Acquired on the Phoenix ICON. Pediatric wide-field fundus photograph
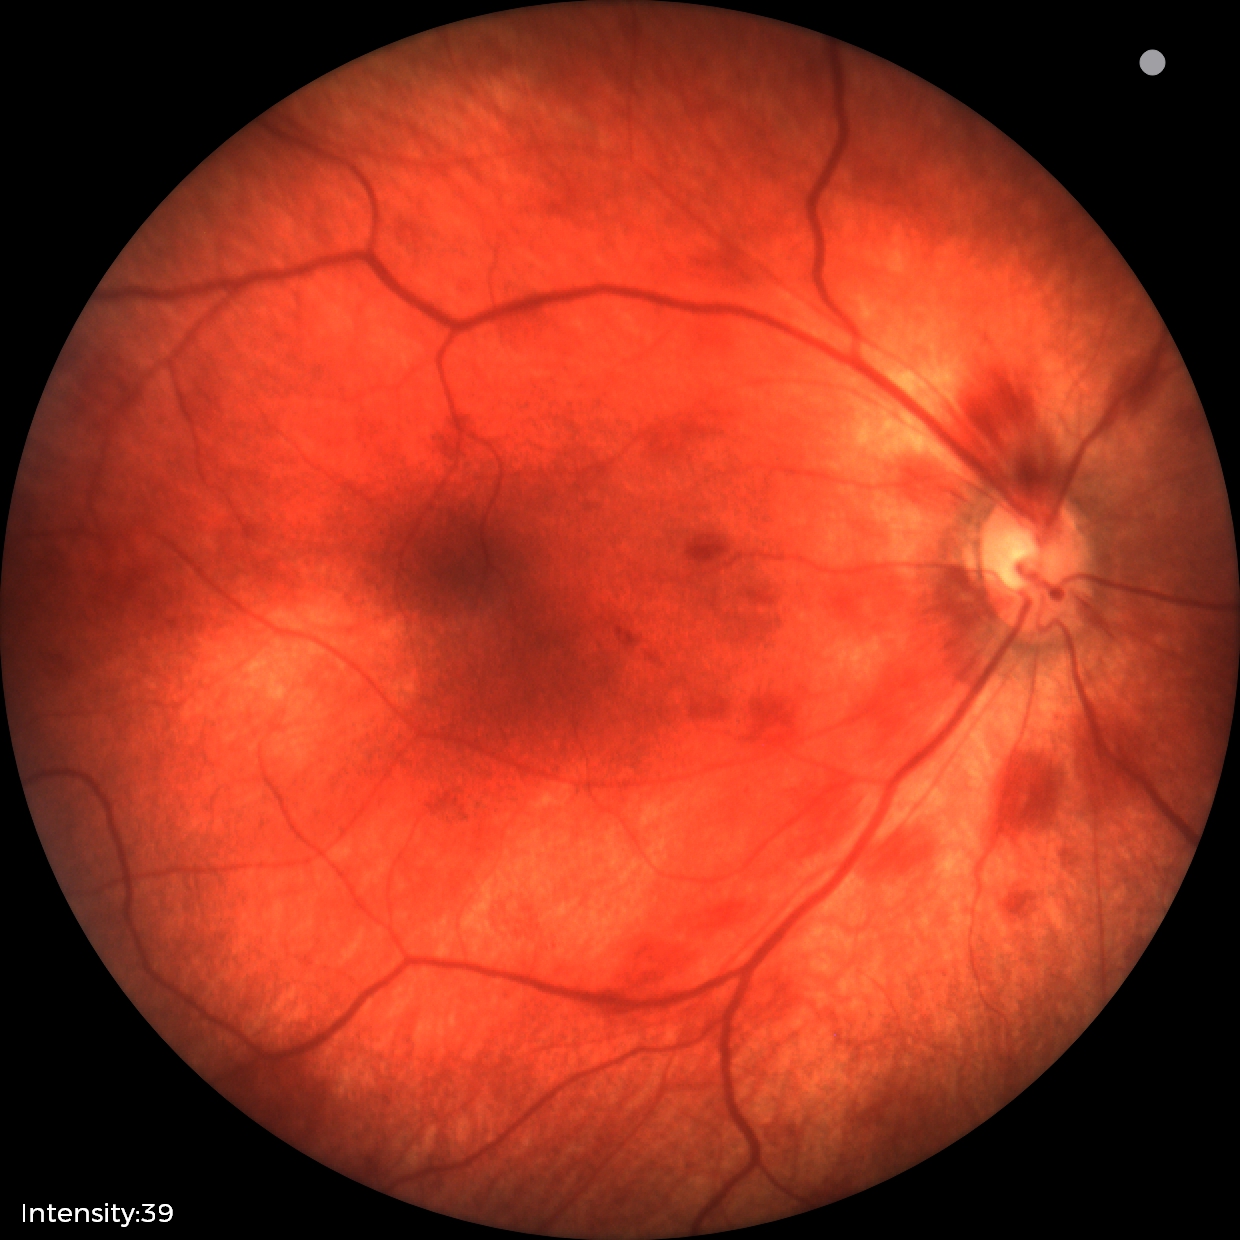
Screening examination consistent with retinal hemorrhages.